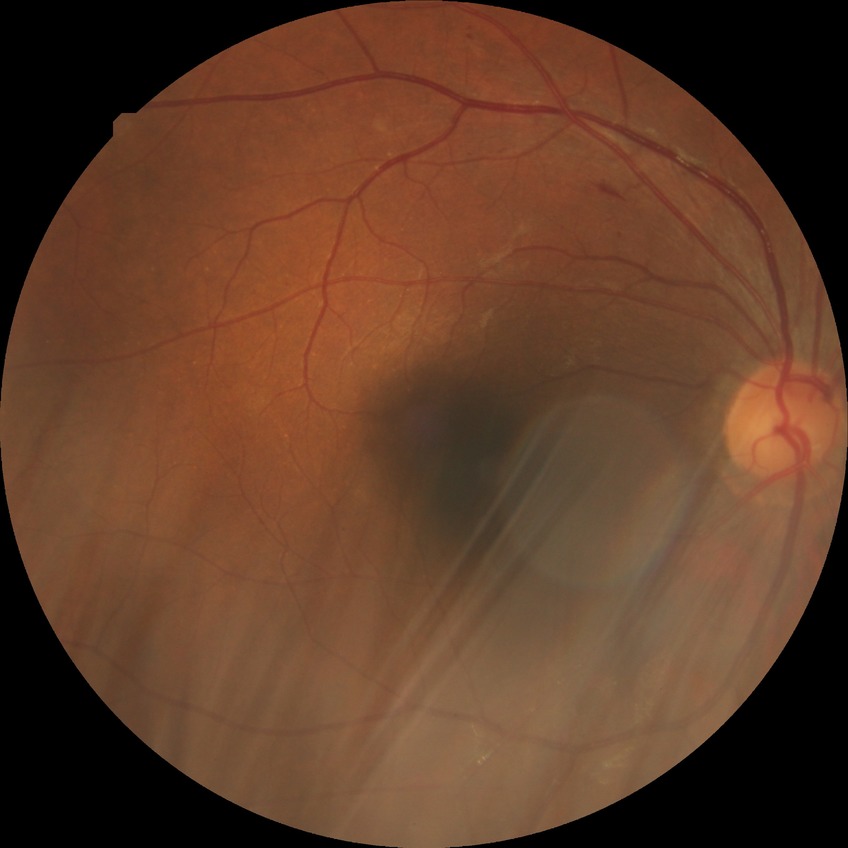
DR grade: SDR.